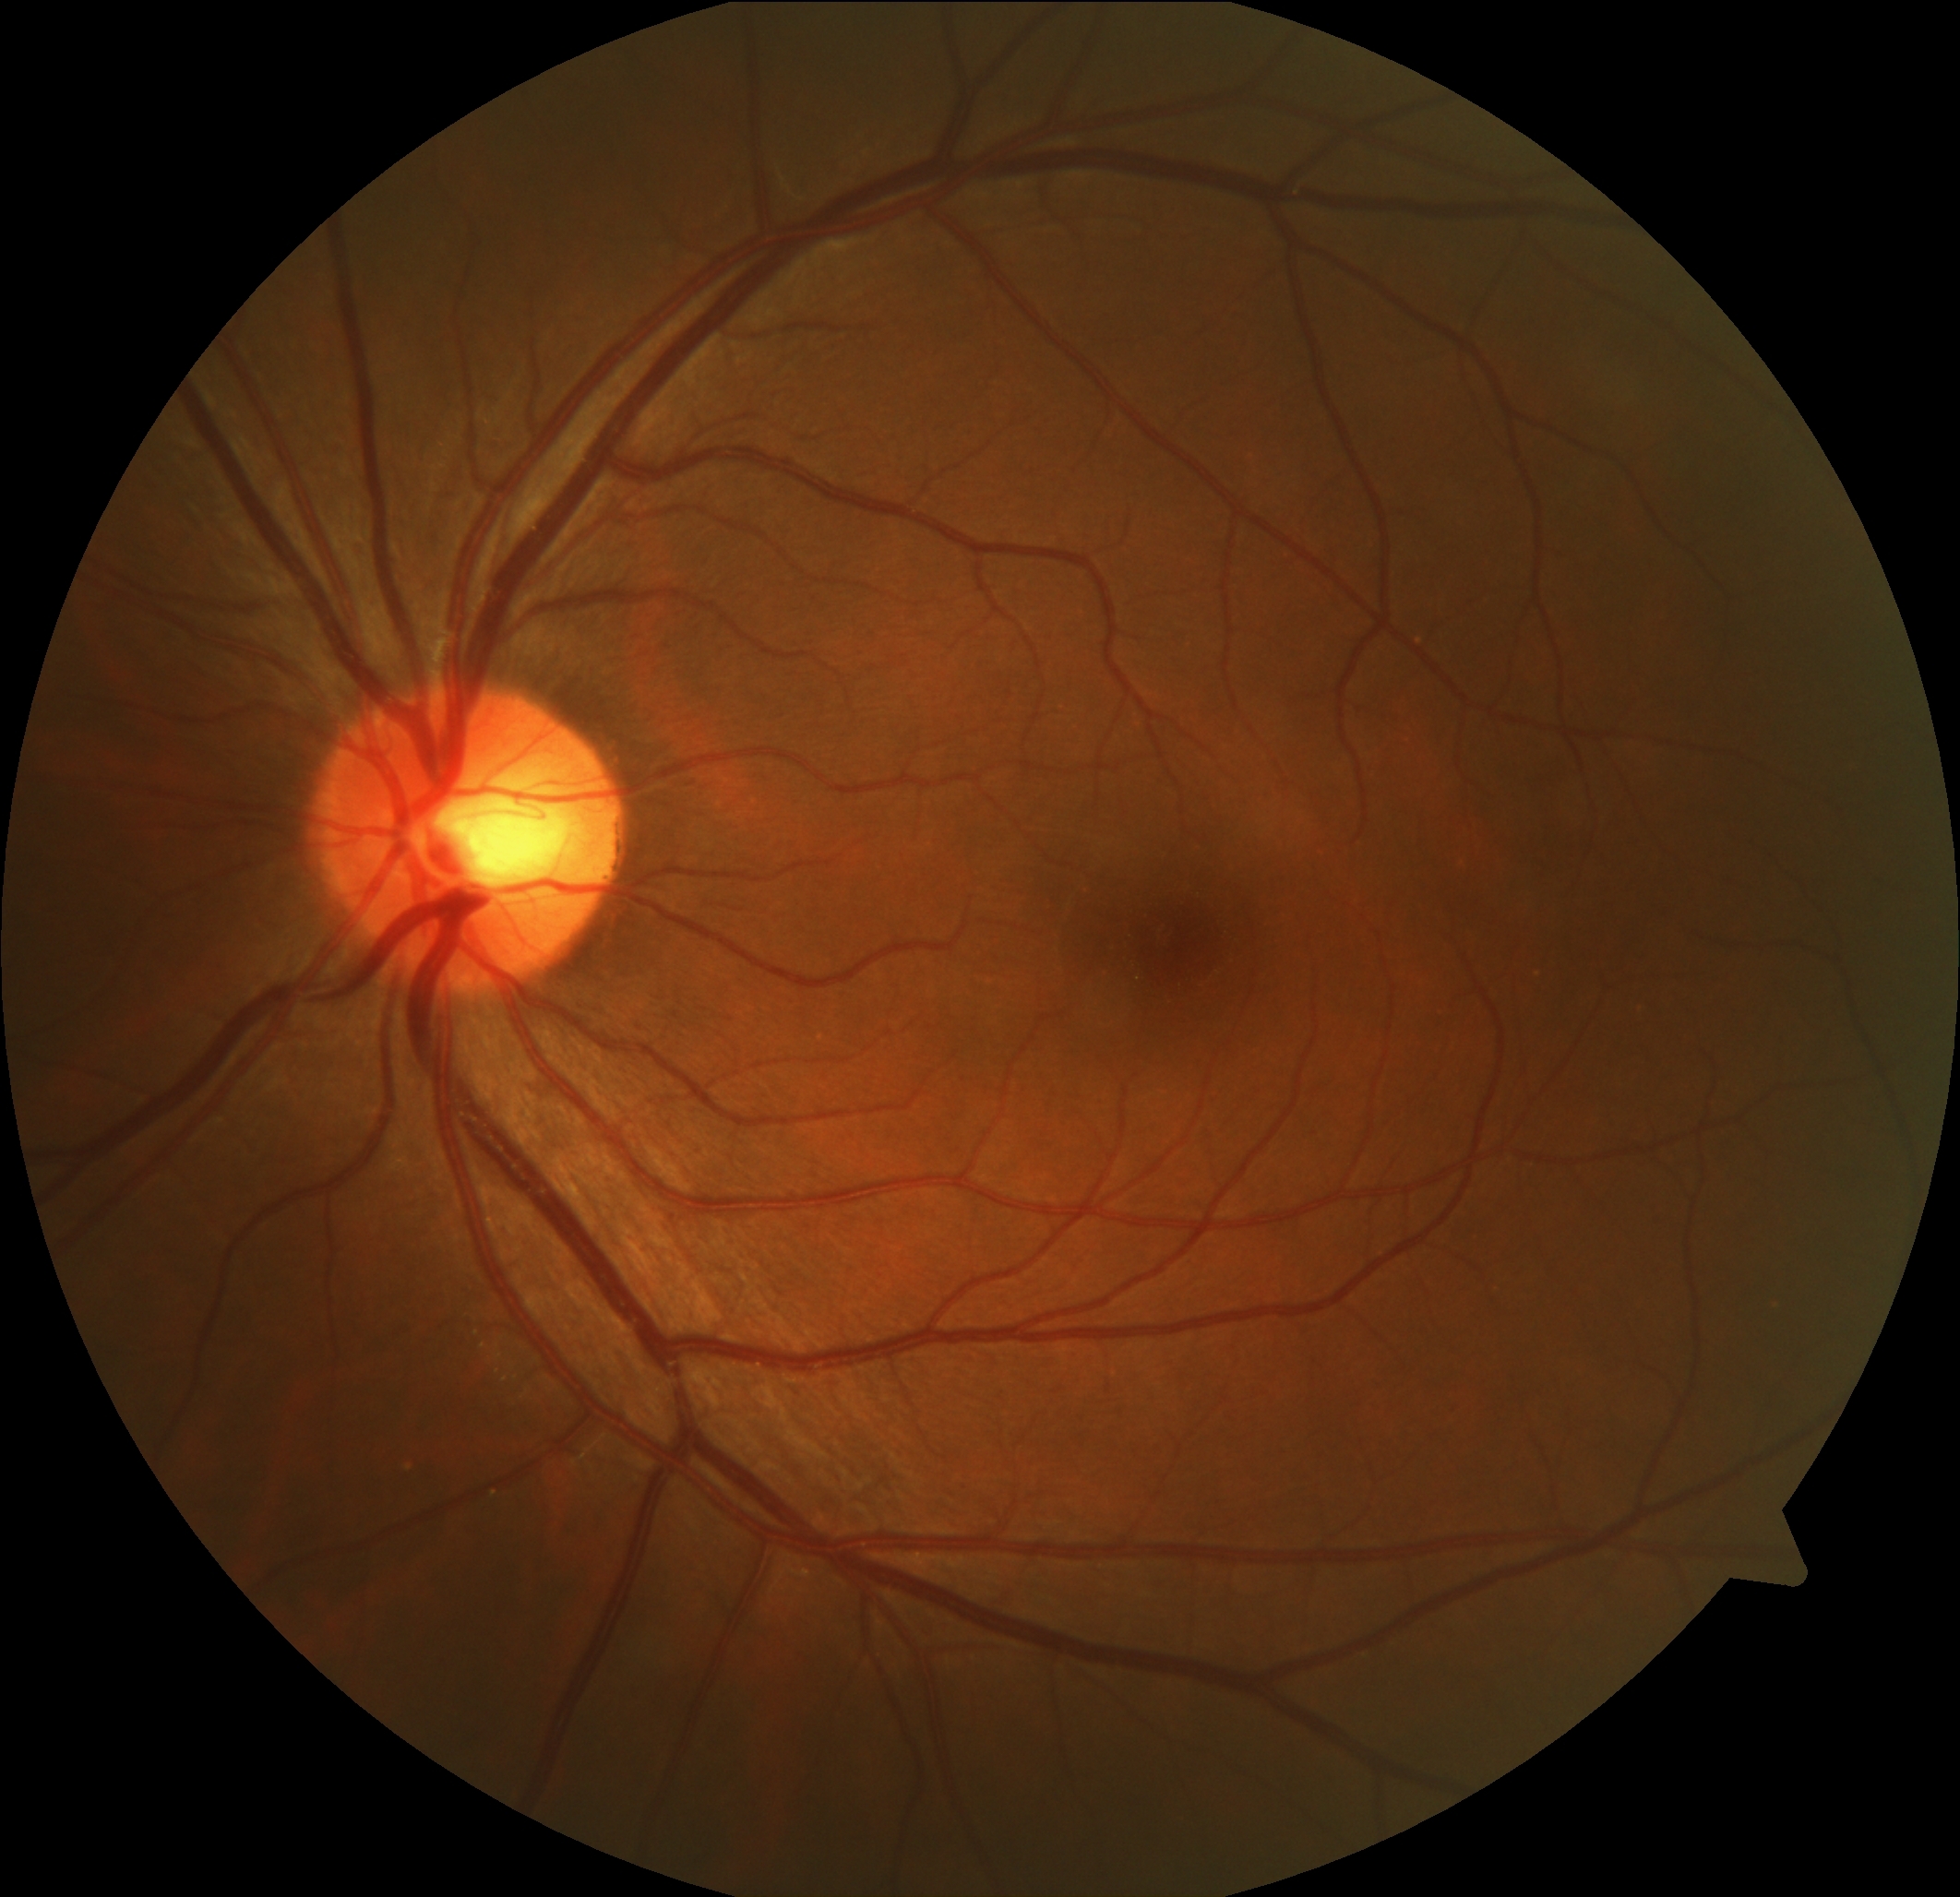
DR severity: grade 0.